Image size 2352x1568: 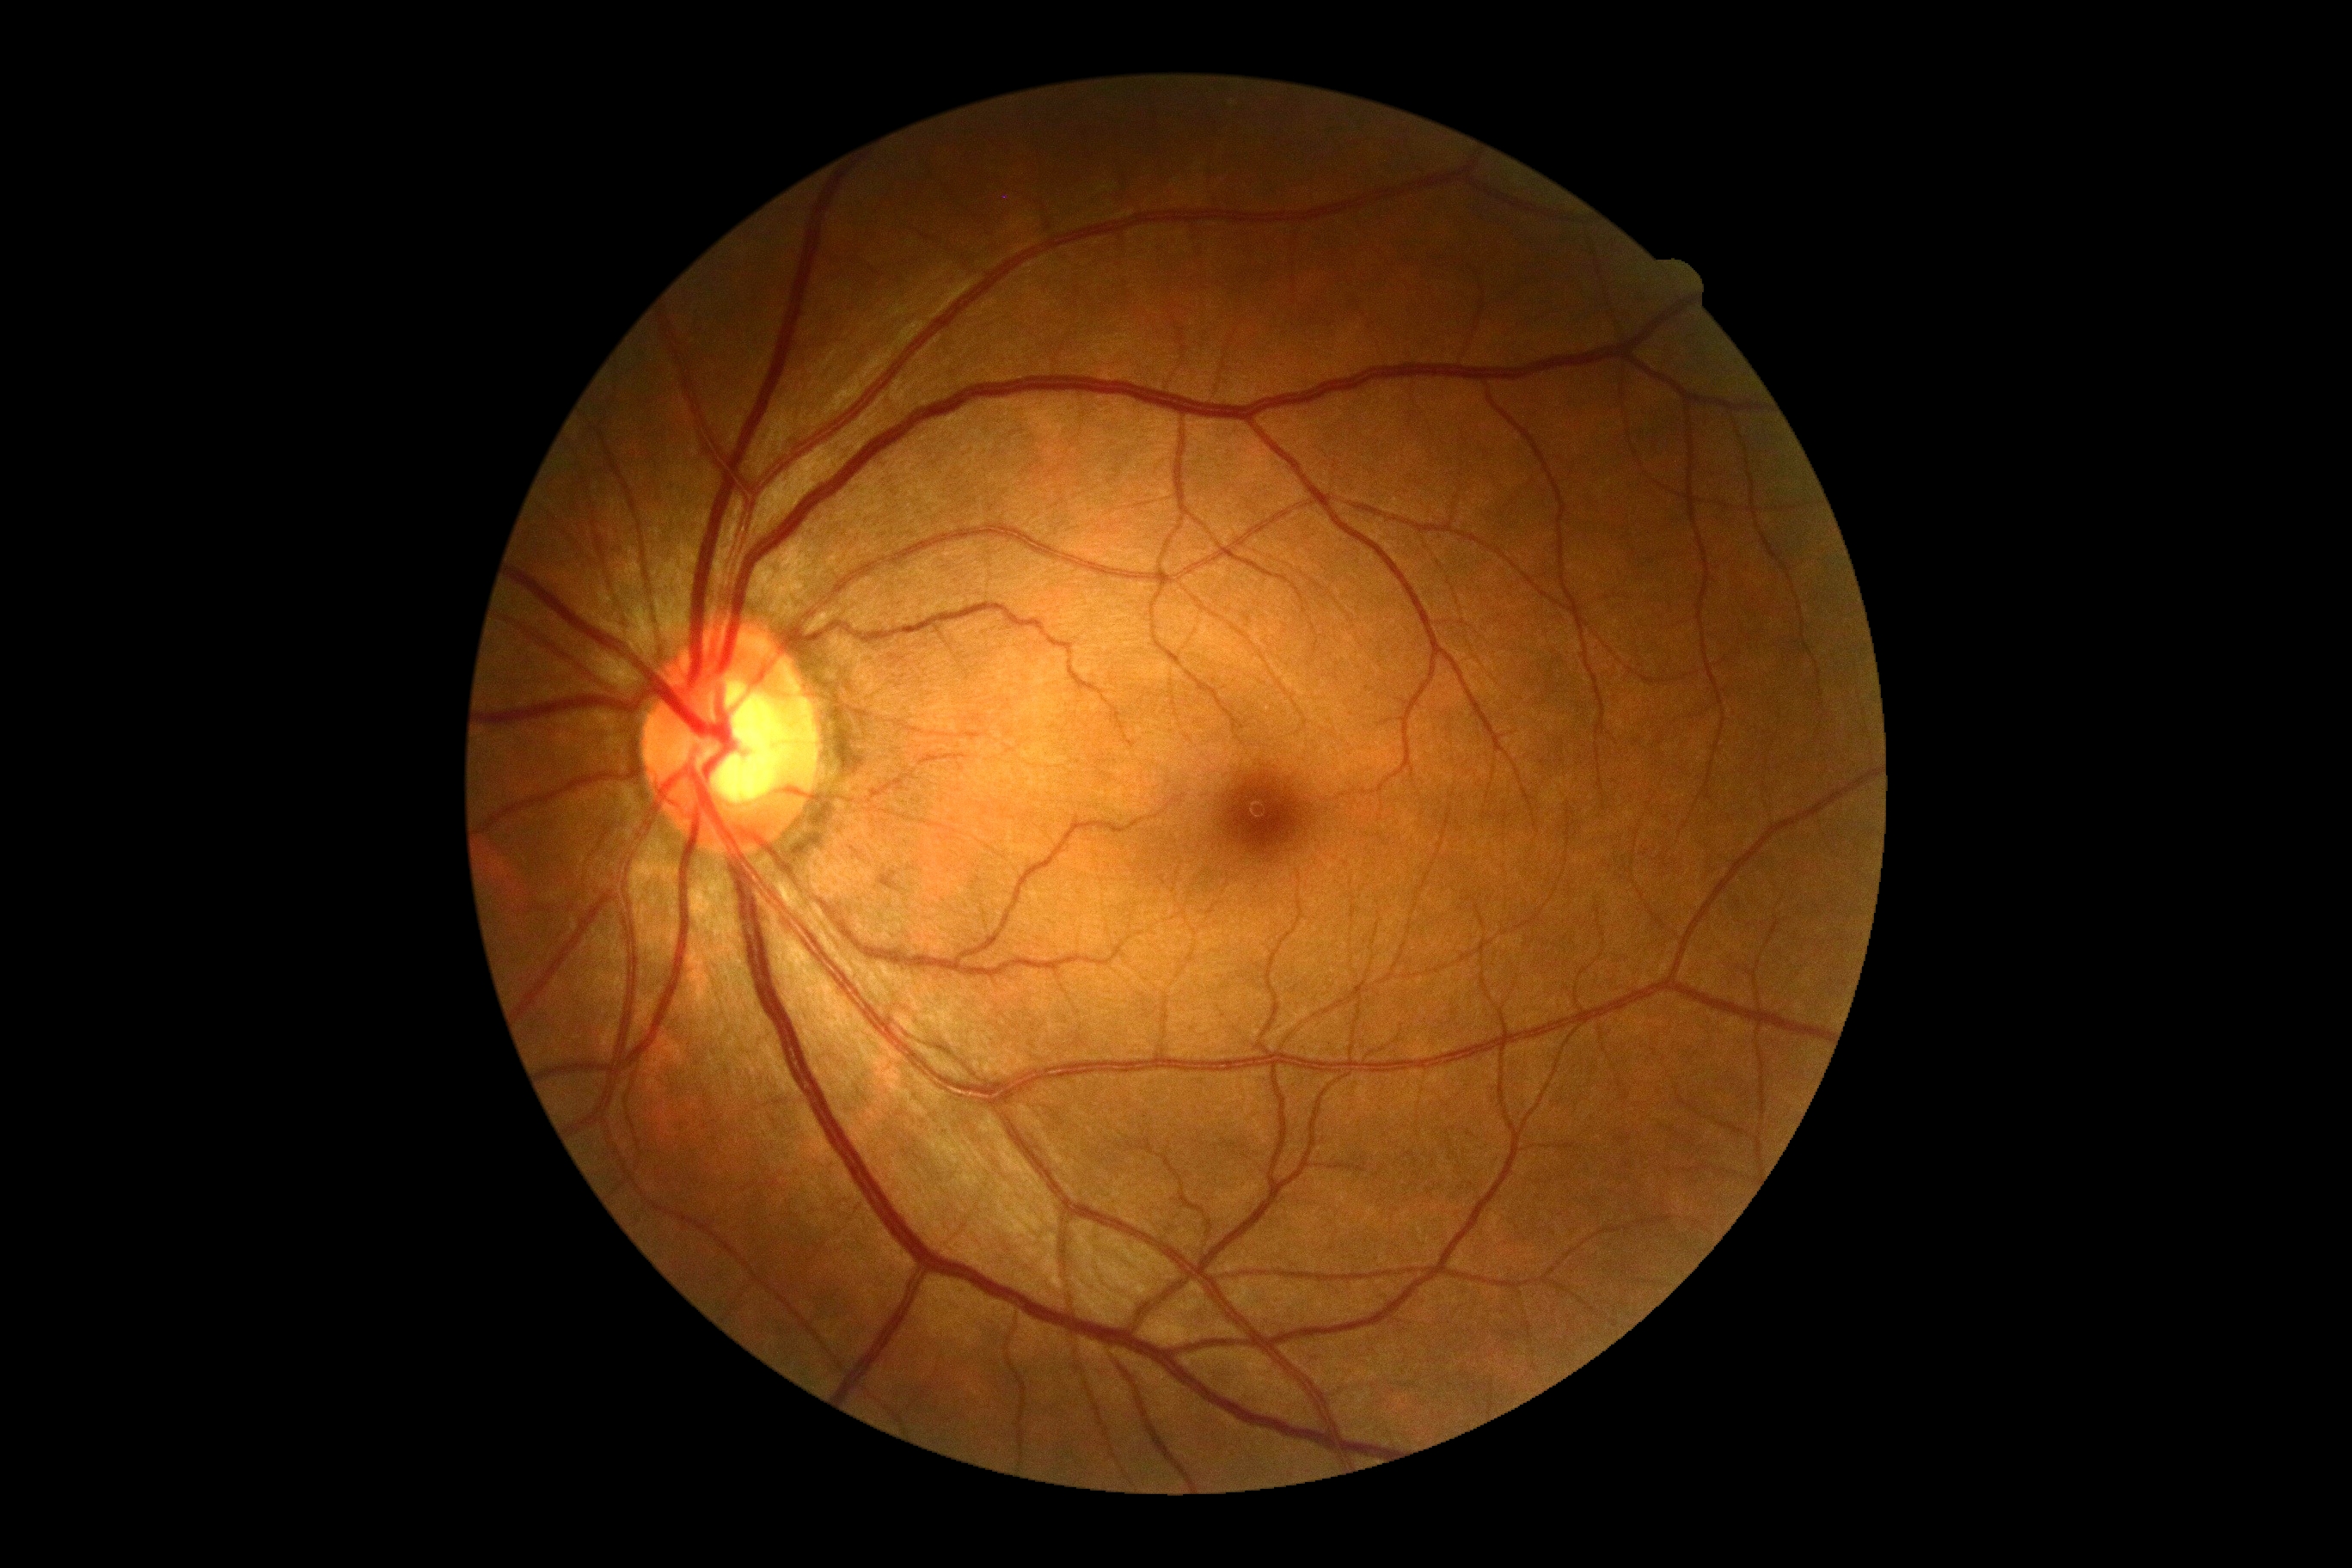 DR impression@no DR findings; DR stage@0 — no visible signs of diabetic retinopathy.